Fundus photo · 2352 by 1568 pixels — 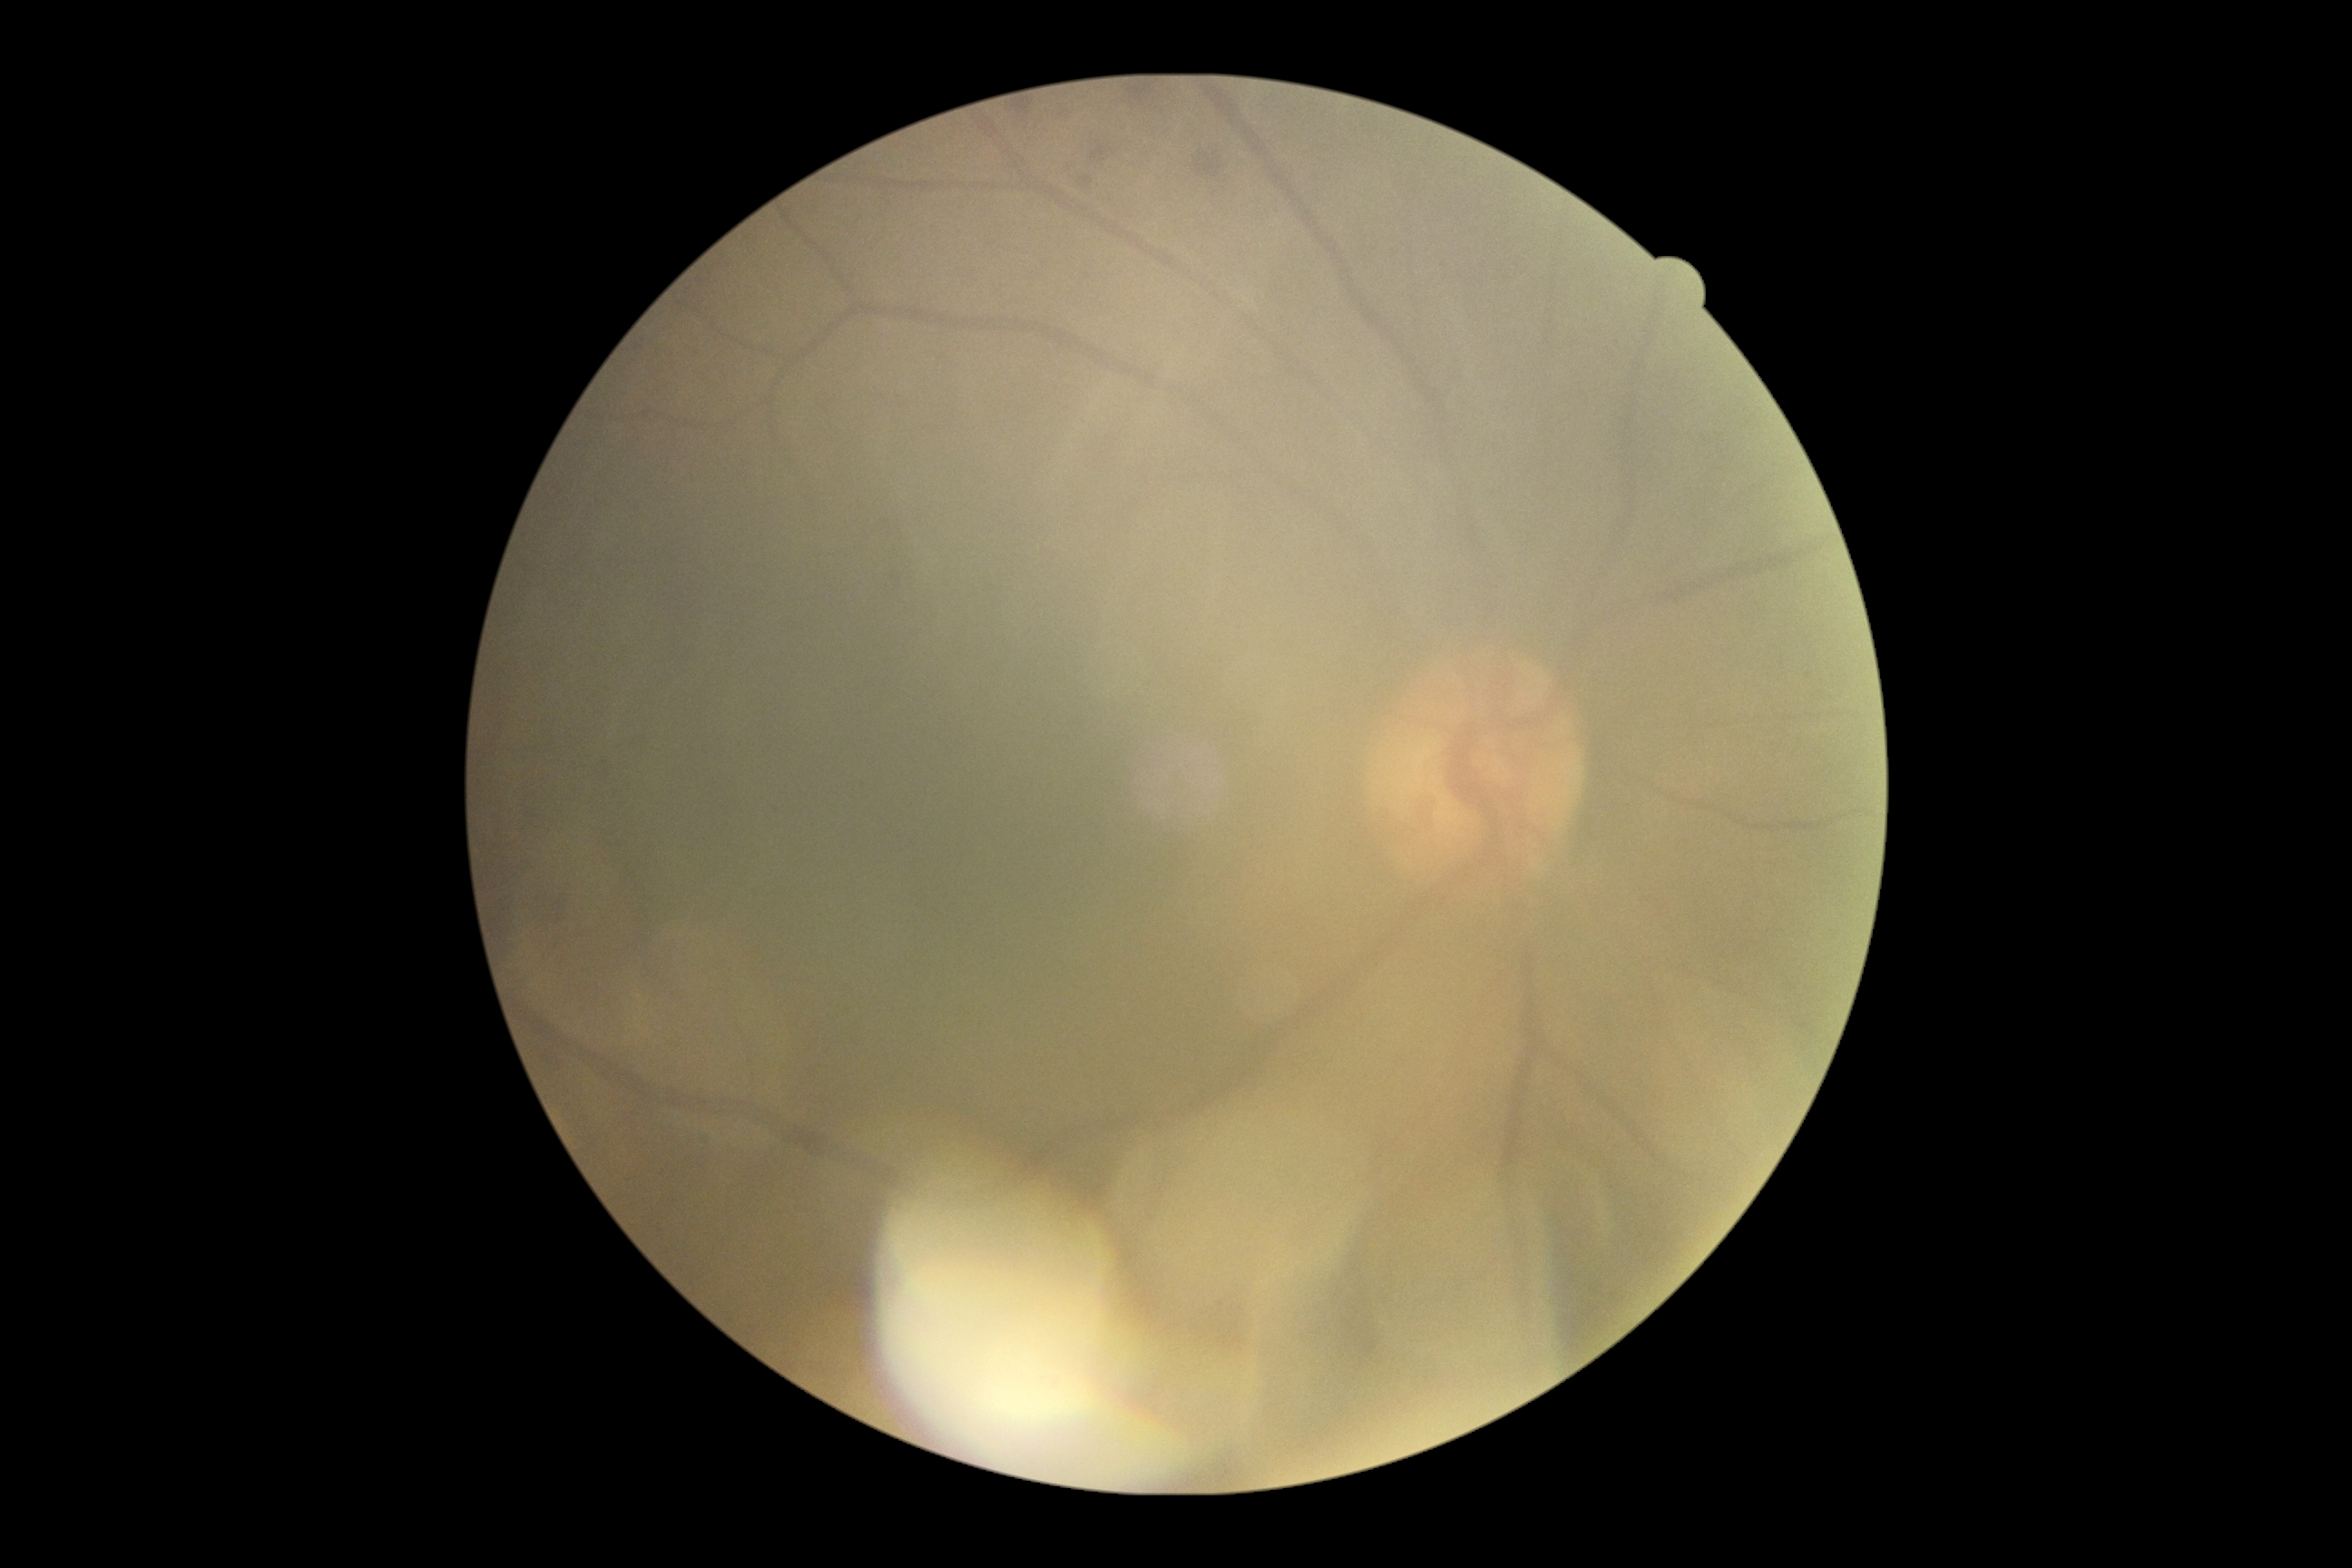

Diabetic retinopathy: moderate non-proliferative diabetic retinopathy (grade 2).